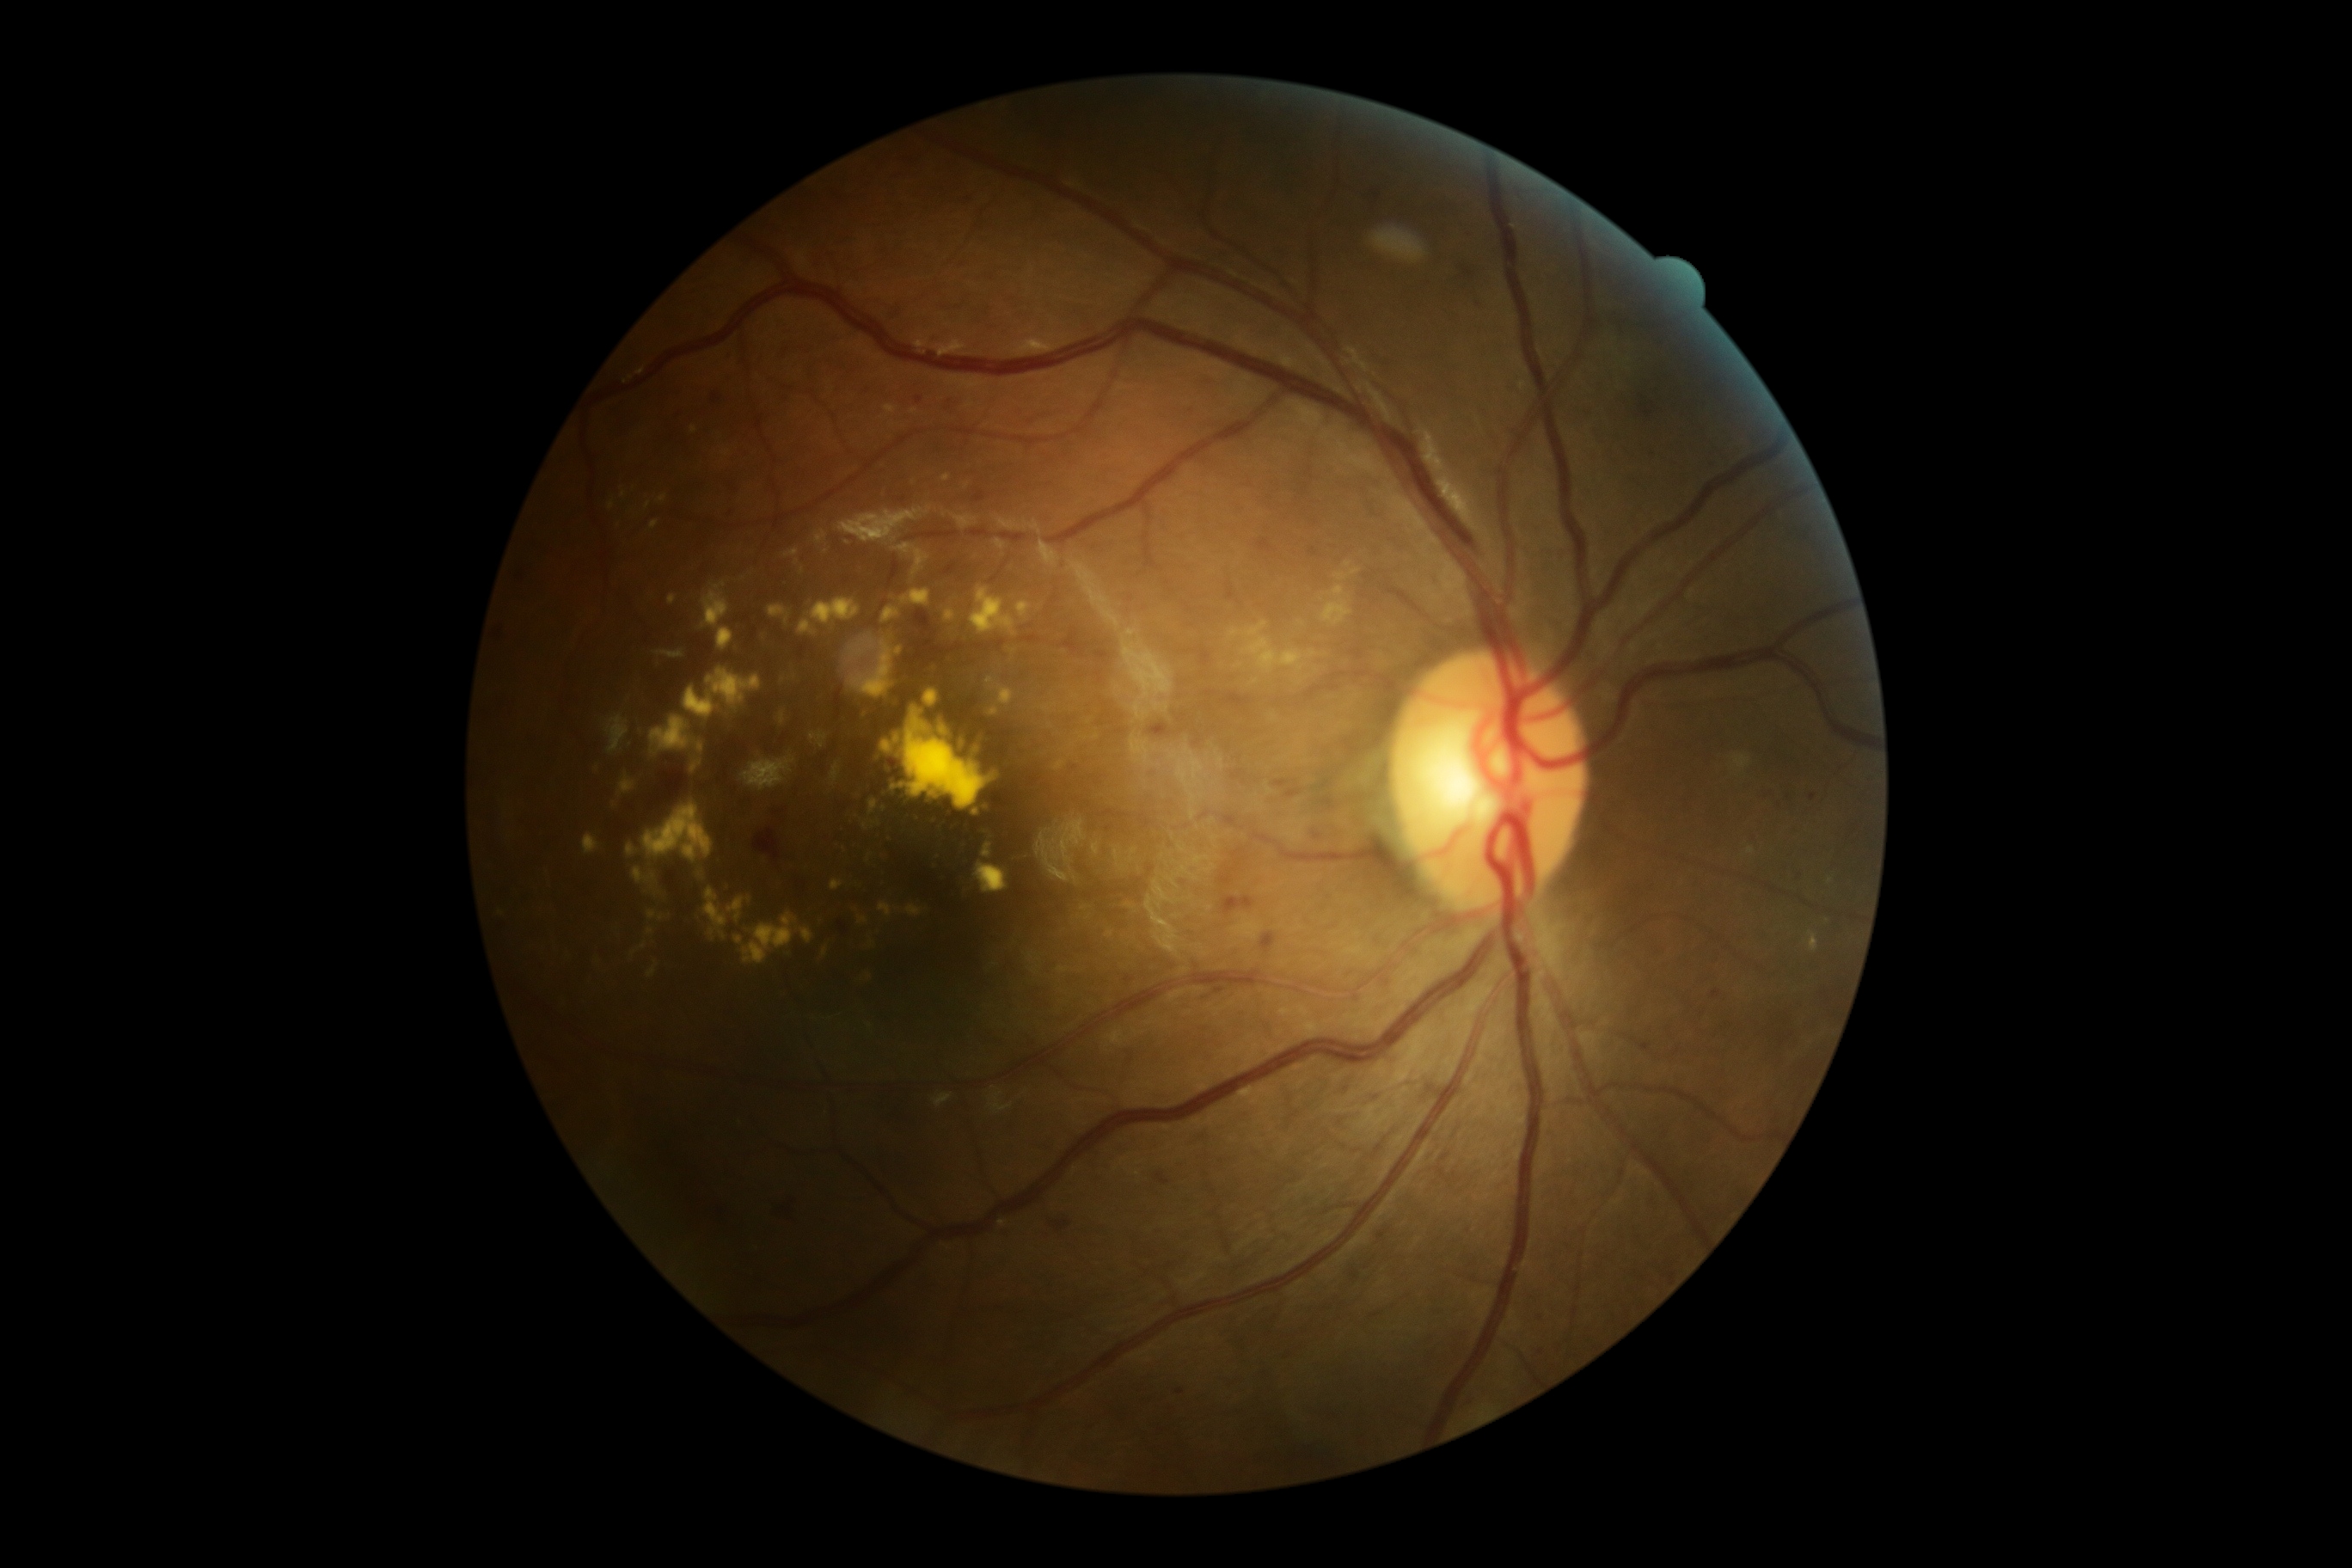 Diabetic retinopathy: moderate NPDR (grade 2)
A subset of detected lesions:
hemorrhages = bbox=(1155, 1173, 1170, 1185), bbox=(1053, 1220, 1074, 1234), bbox=(914, 609, 936, 637), bbox=(943, 565, 957, 577), bbox=(1643, 405, 1653, 419), bbox=(778, 1197, 795, 1222), bbox=(879, 1096, 912, 1129), bbox=(1149, 725, 1172, 738), bbox=(1462, 267, 1474, 278), bbox=(654, 769, 687, 804), bbox=(1273, 781, 1289, 788), bbox=(1285, 790, 1301, 799), bbox=(754, 830, 781, 861), bbox=(1223, 897, 1254, 916), bbox=(1261, 933, 1277, 952), bbox=(1313, 826, 1323, 836), bbox=(838, 921, 848, 936)
microaneurysms (subset) = bbox=(898, 498, 907, 503), bbox=(1713, 991, 1720, 1000), bbox=(1351, 1270, 1359, 1282), bbox=(1175, 1388, 1185, 1395), bbox=(711, 393, 720, 405), bbox=(974, 493, 986, 503)
Smaller microaneurysms around (x=1813, y=798), (x=1381, y=1236), (x=1542, y=1353), (x=1377, y=197), (x=1542, y=1315), (x=1789, y=798), (x=1767, y=791), (x=1476, y=300), (x=1780, y=806), (x=919, y=401)
soft exudates = not present
hard exudates (subset) = bbox=(895, 735, 900, 745), bbox=(647, 928, 654, 936), bbox=(778, 711, 787, 726), bbox=(903, 707, 991, 811), bbox=(881, 740, 900, 756), bbox=(924, 689, 938, 707), bbox=(910, 408, 919, 415), bbox=(668, 594, 677, 606), bbox=(718, 628, 733, 651), bbox=(792, 673, 797, 682), bbox=(986, 677, 1015, 706), bbox=(807, 599, 861, 625), bbox=(848, 642, 891, 699), bbox=(647, 964, 659, 979), bbox=(728, 898, 745, 922), bbox=(699, 869, 707, 879), bbox=(945, 609, 957, 622)
Smaller hard exudates around (x=1831, y=881), (x=938, y=859), (x=902, y=785)